Wide-field contact fundus photograph of an infant · camera: Clarity RetCam 3 (130° FOV).
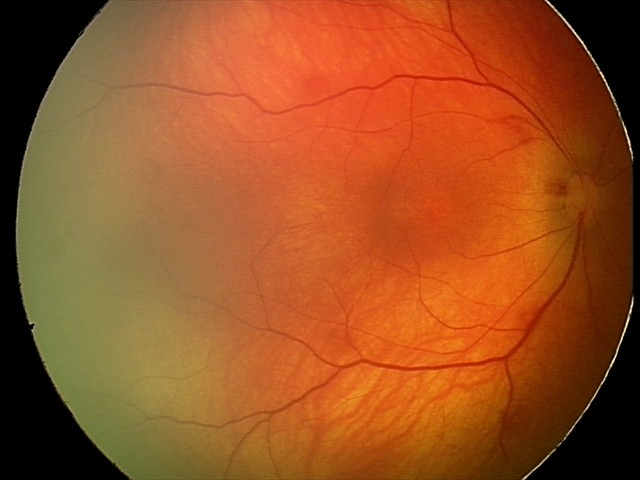 Screening: retinal hemorrhages.